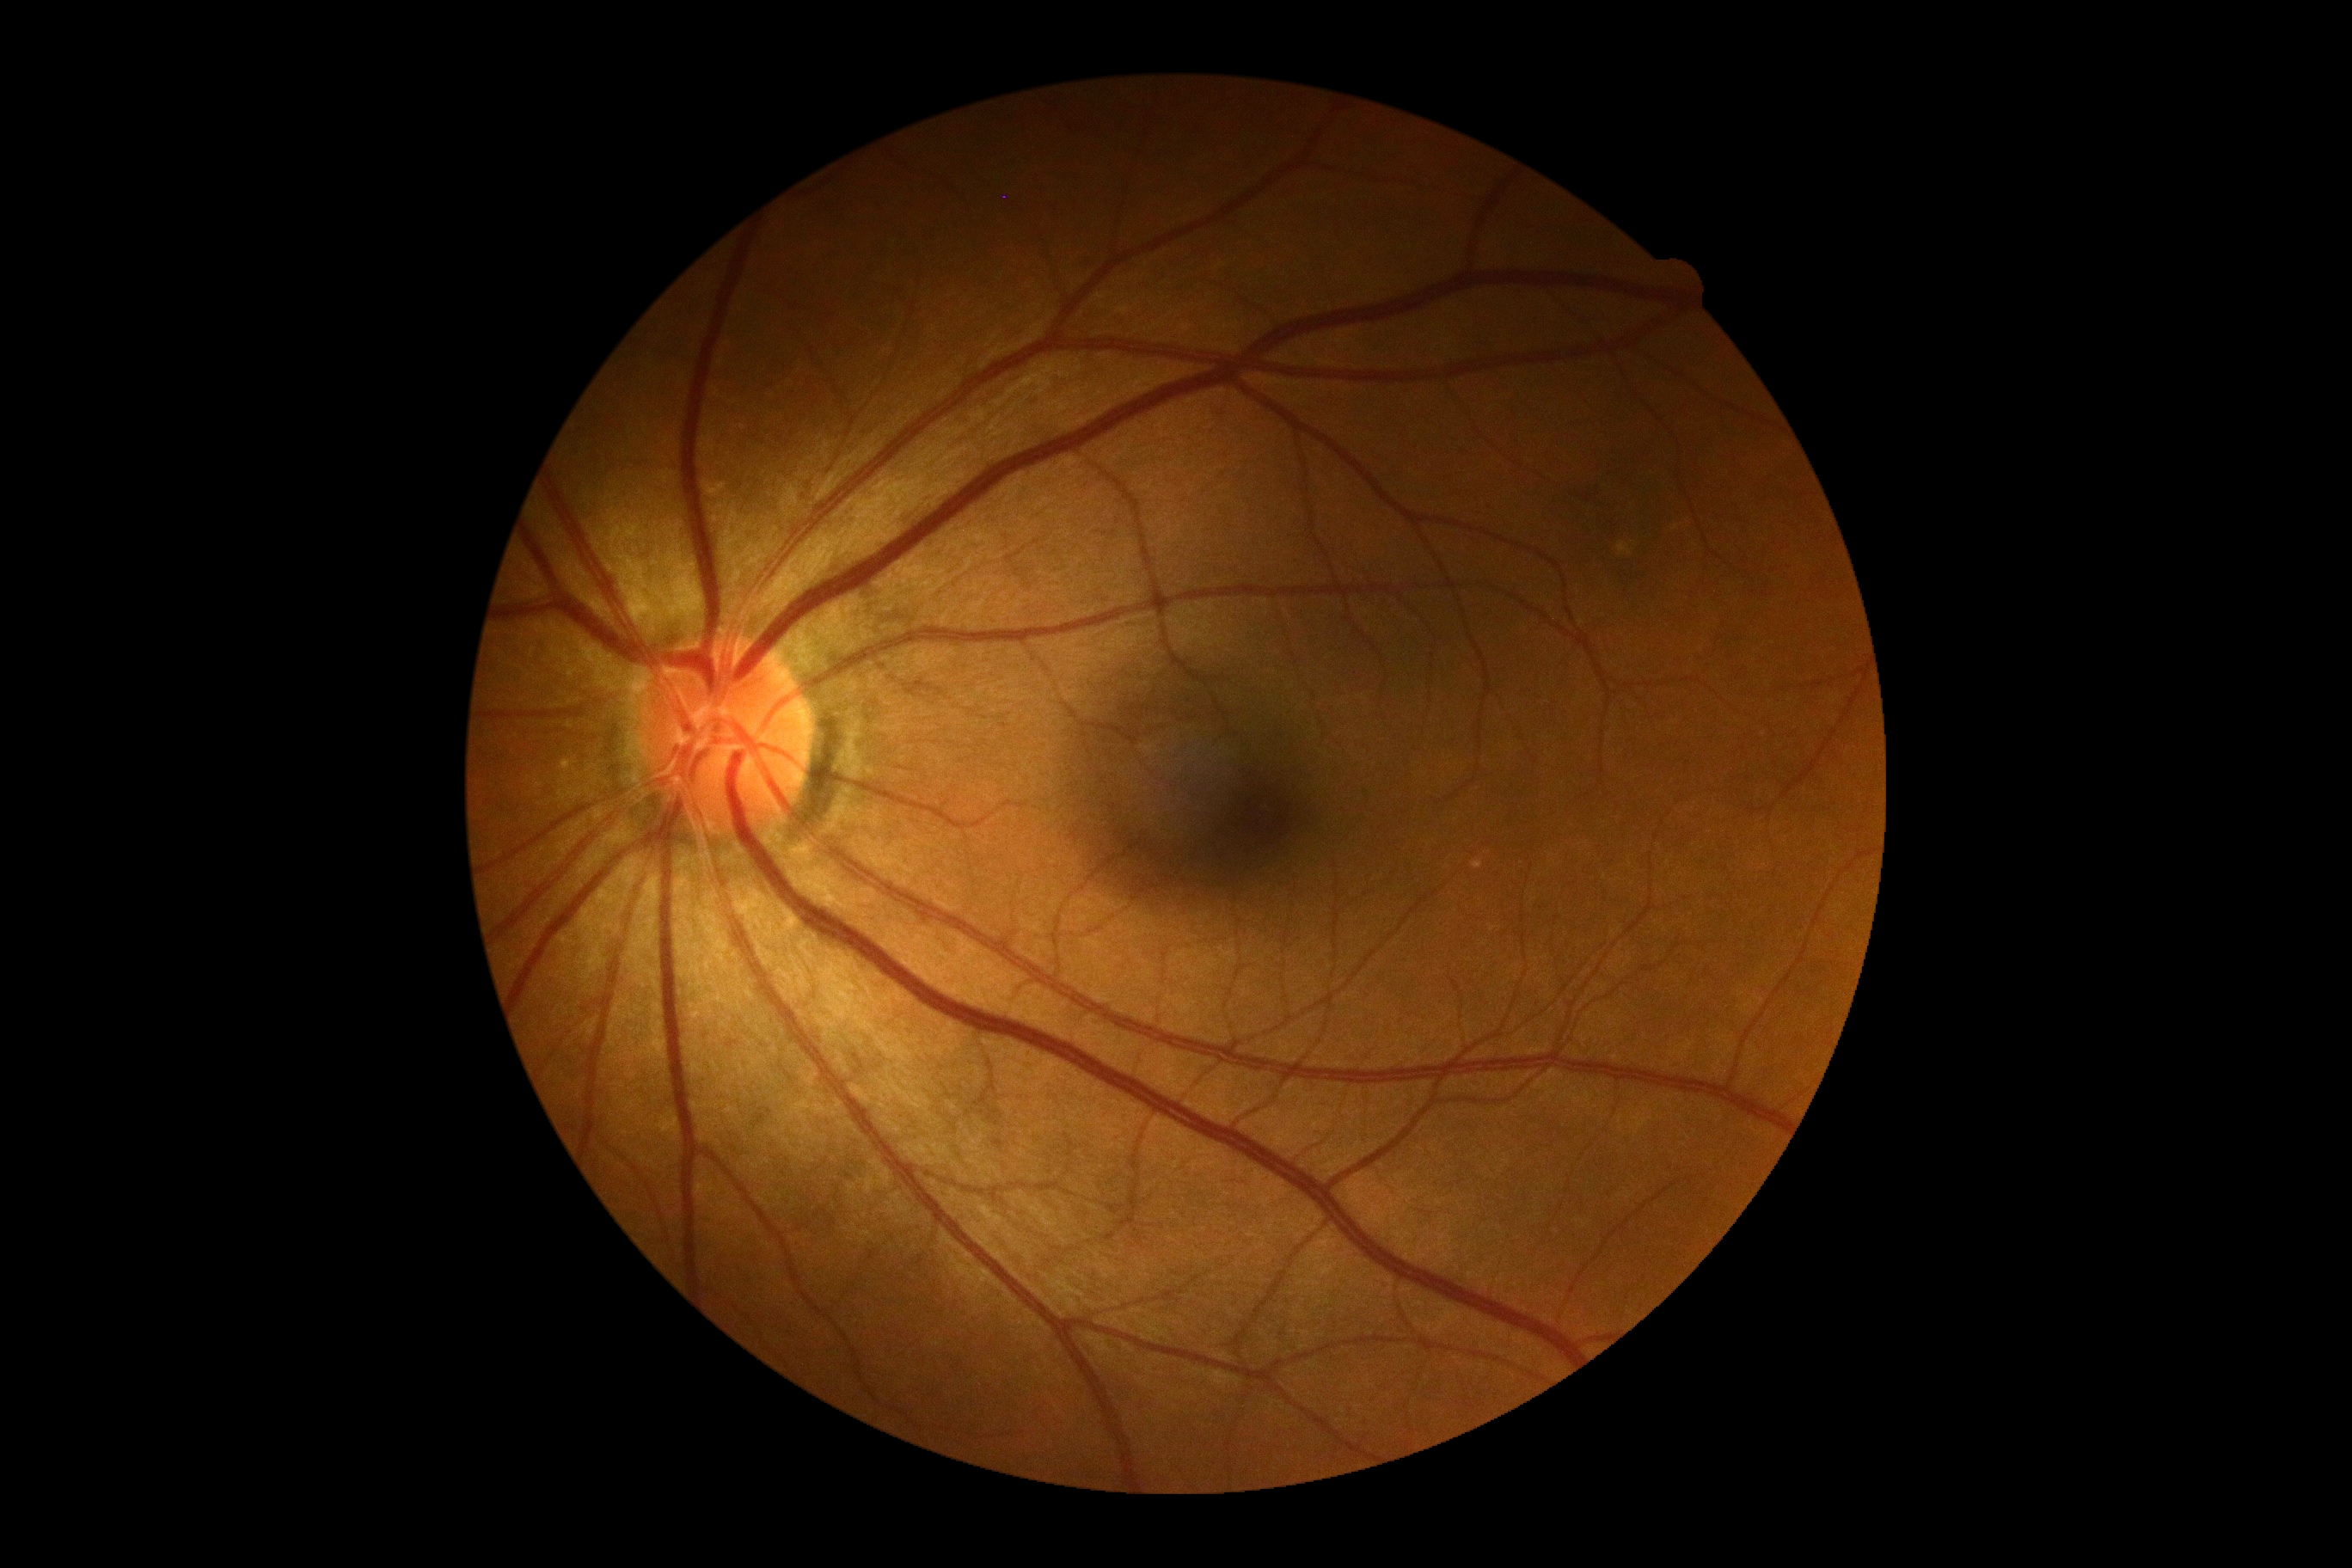

{
  "dr_impression": "no apparent DR",
  "dr_grade": "0/4 — no visible signs of diabetic retinopathy"
}